45° field of view; 1725 by 1721 pixels.
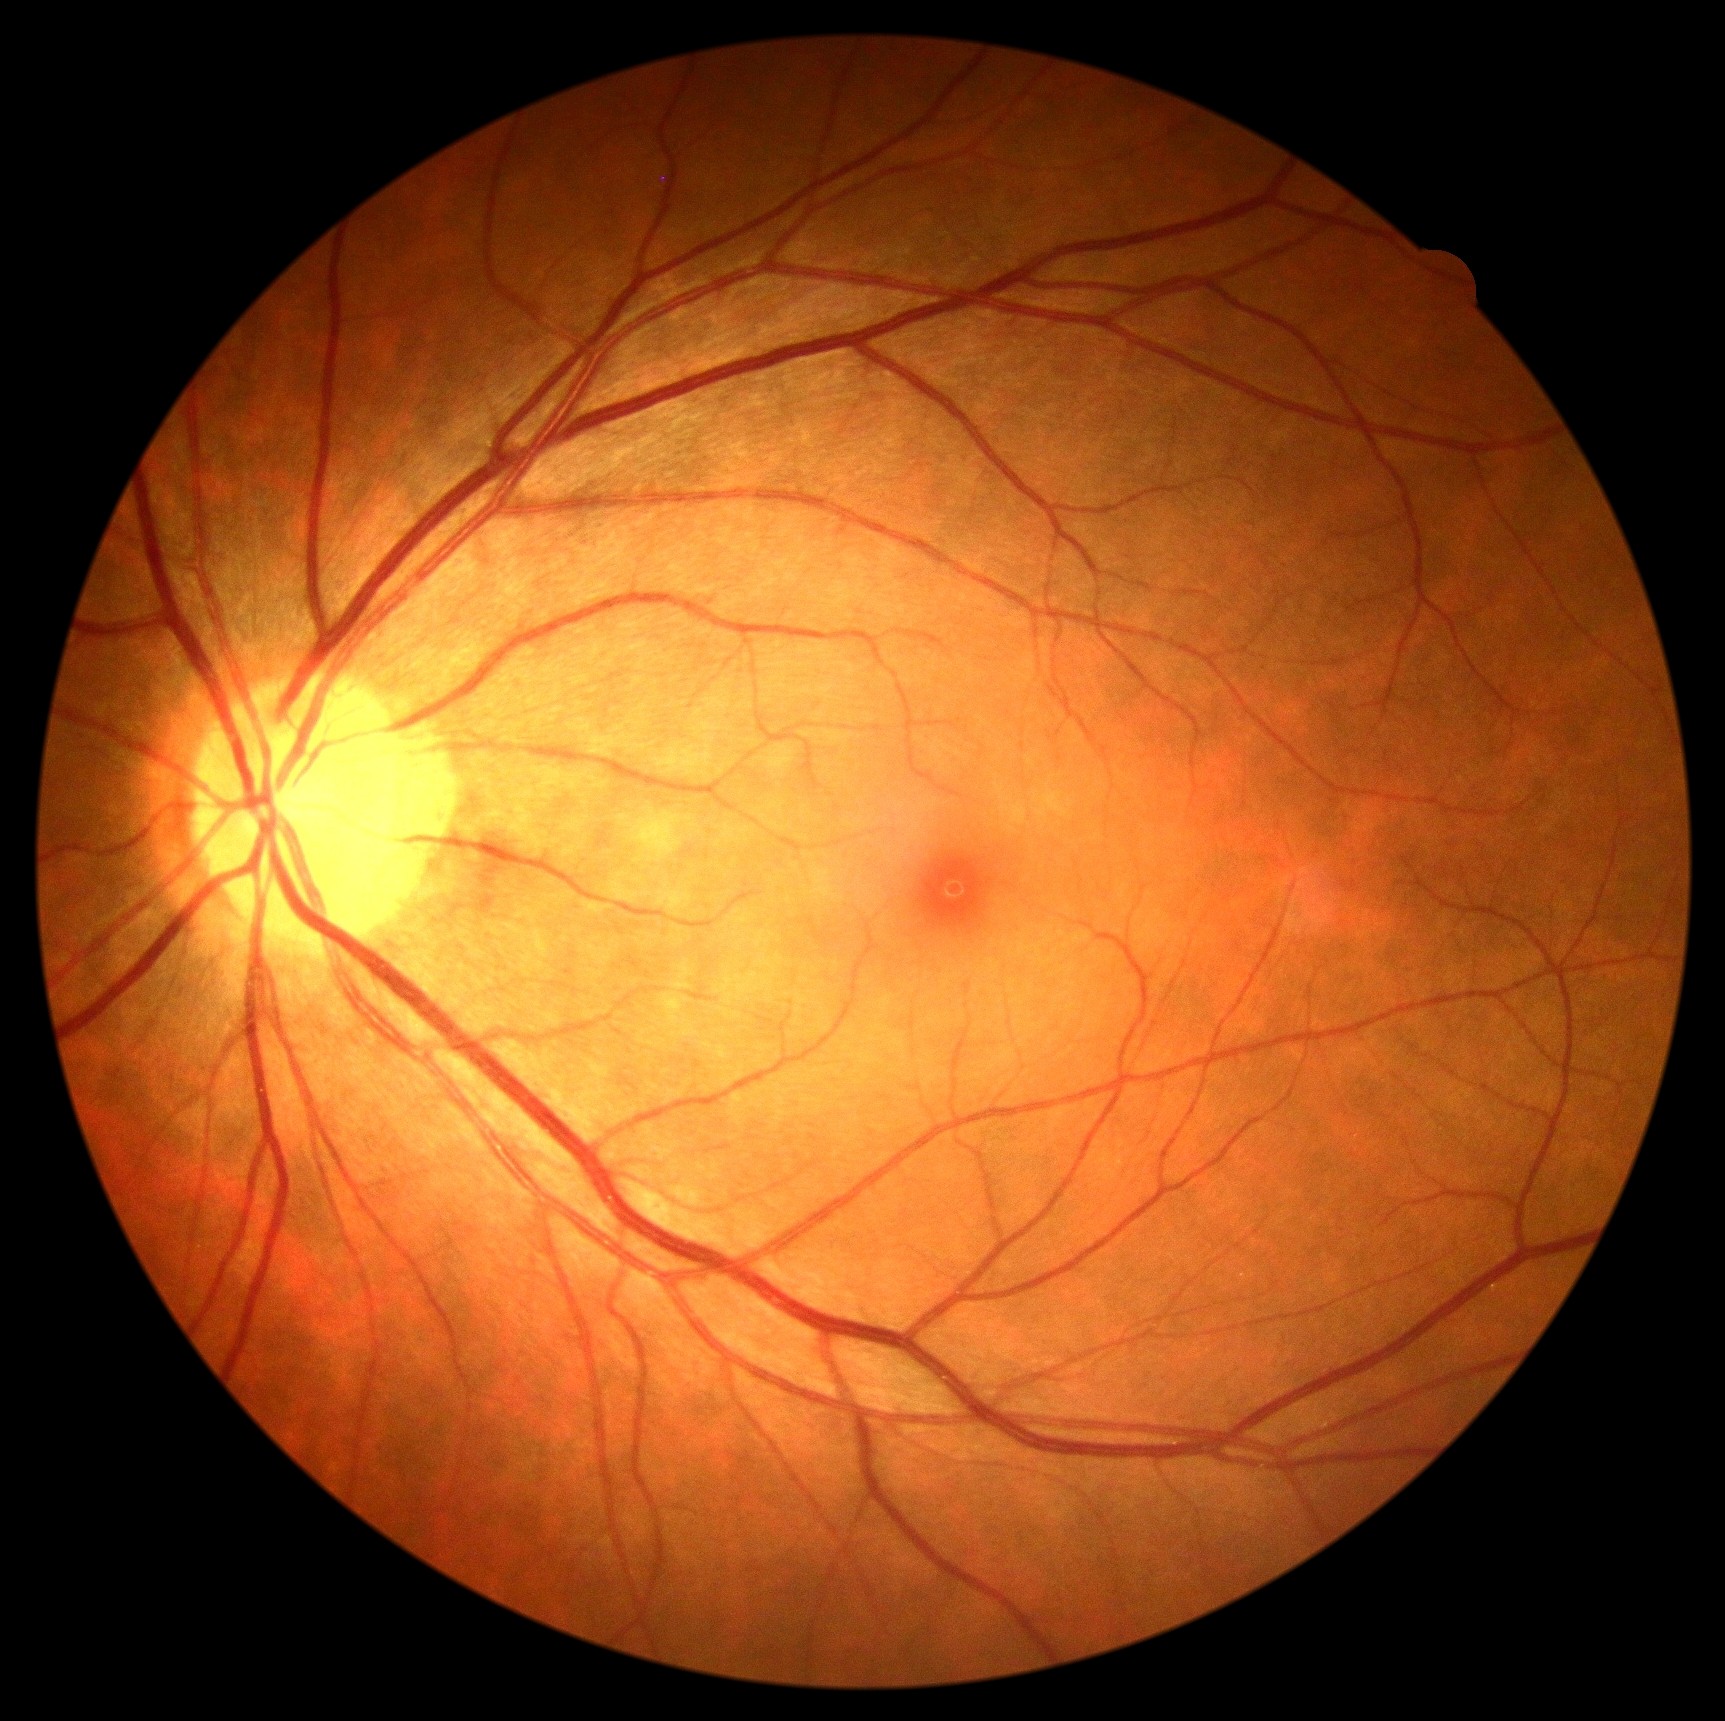
DR stage = 0